Camera: NIDEK AFC-230: 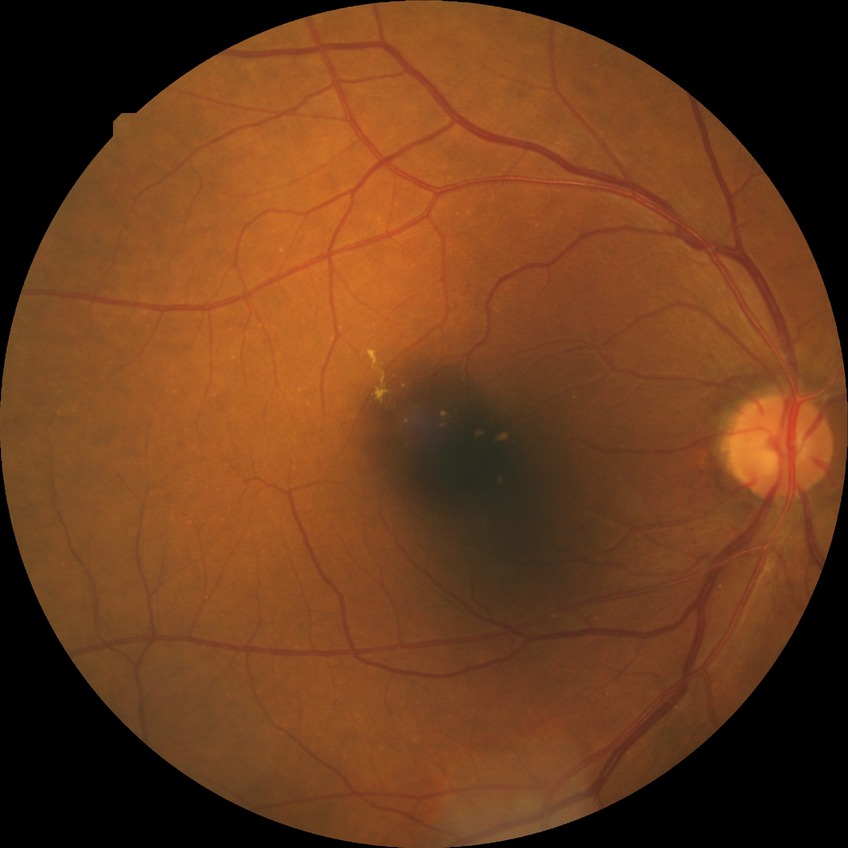
diabetic retinopathy (DR) = SDR (simple diabetic retinopathy)